Nonmydriatic fundus photograph, FOV: 45 degrees:
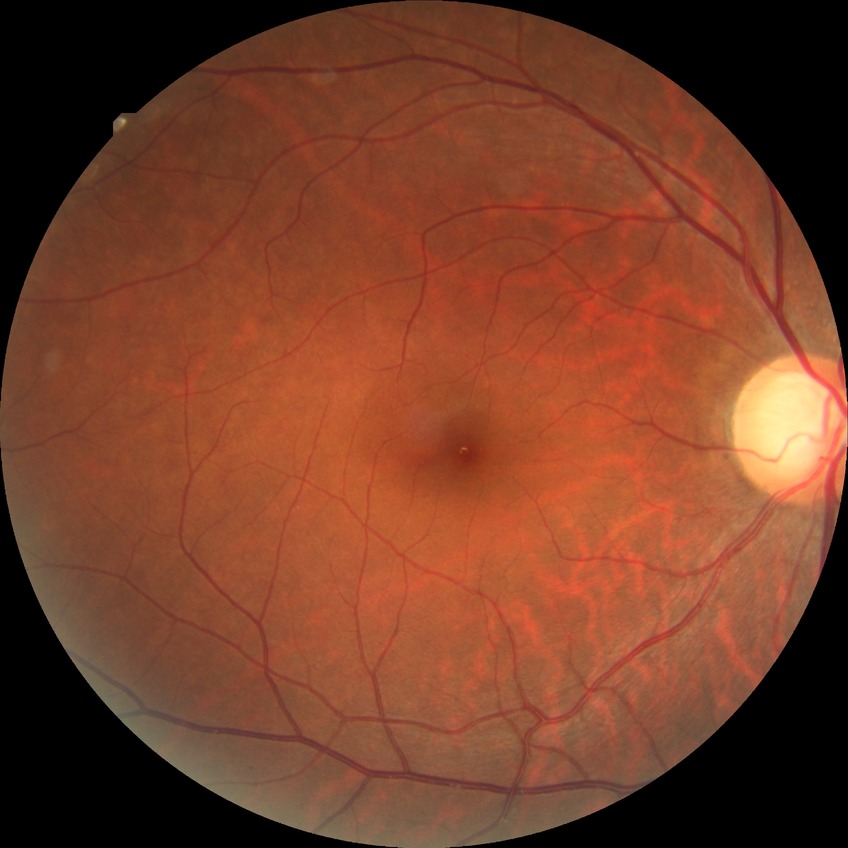

diabetic retinopathy (DR): NDR (no diabetic retinopathy)